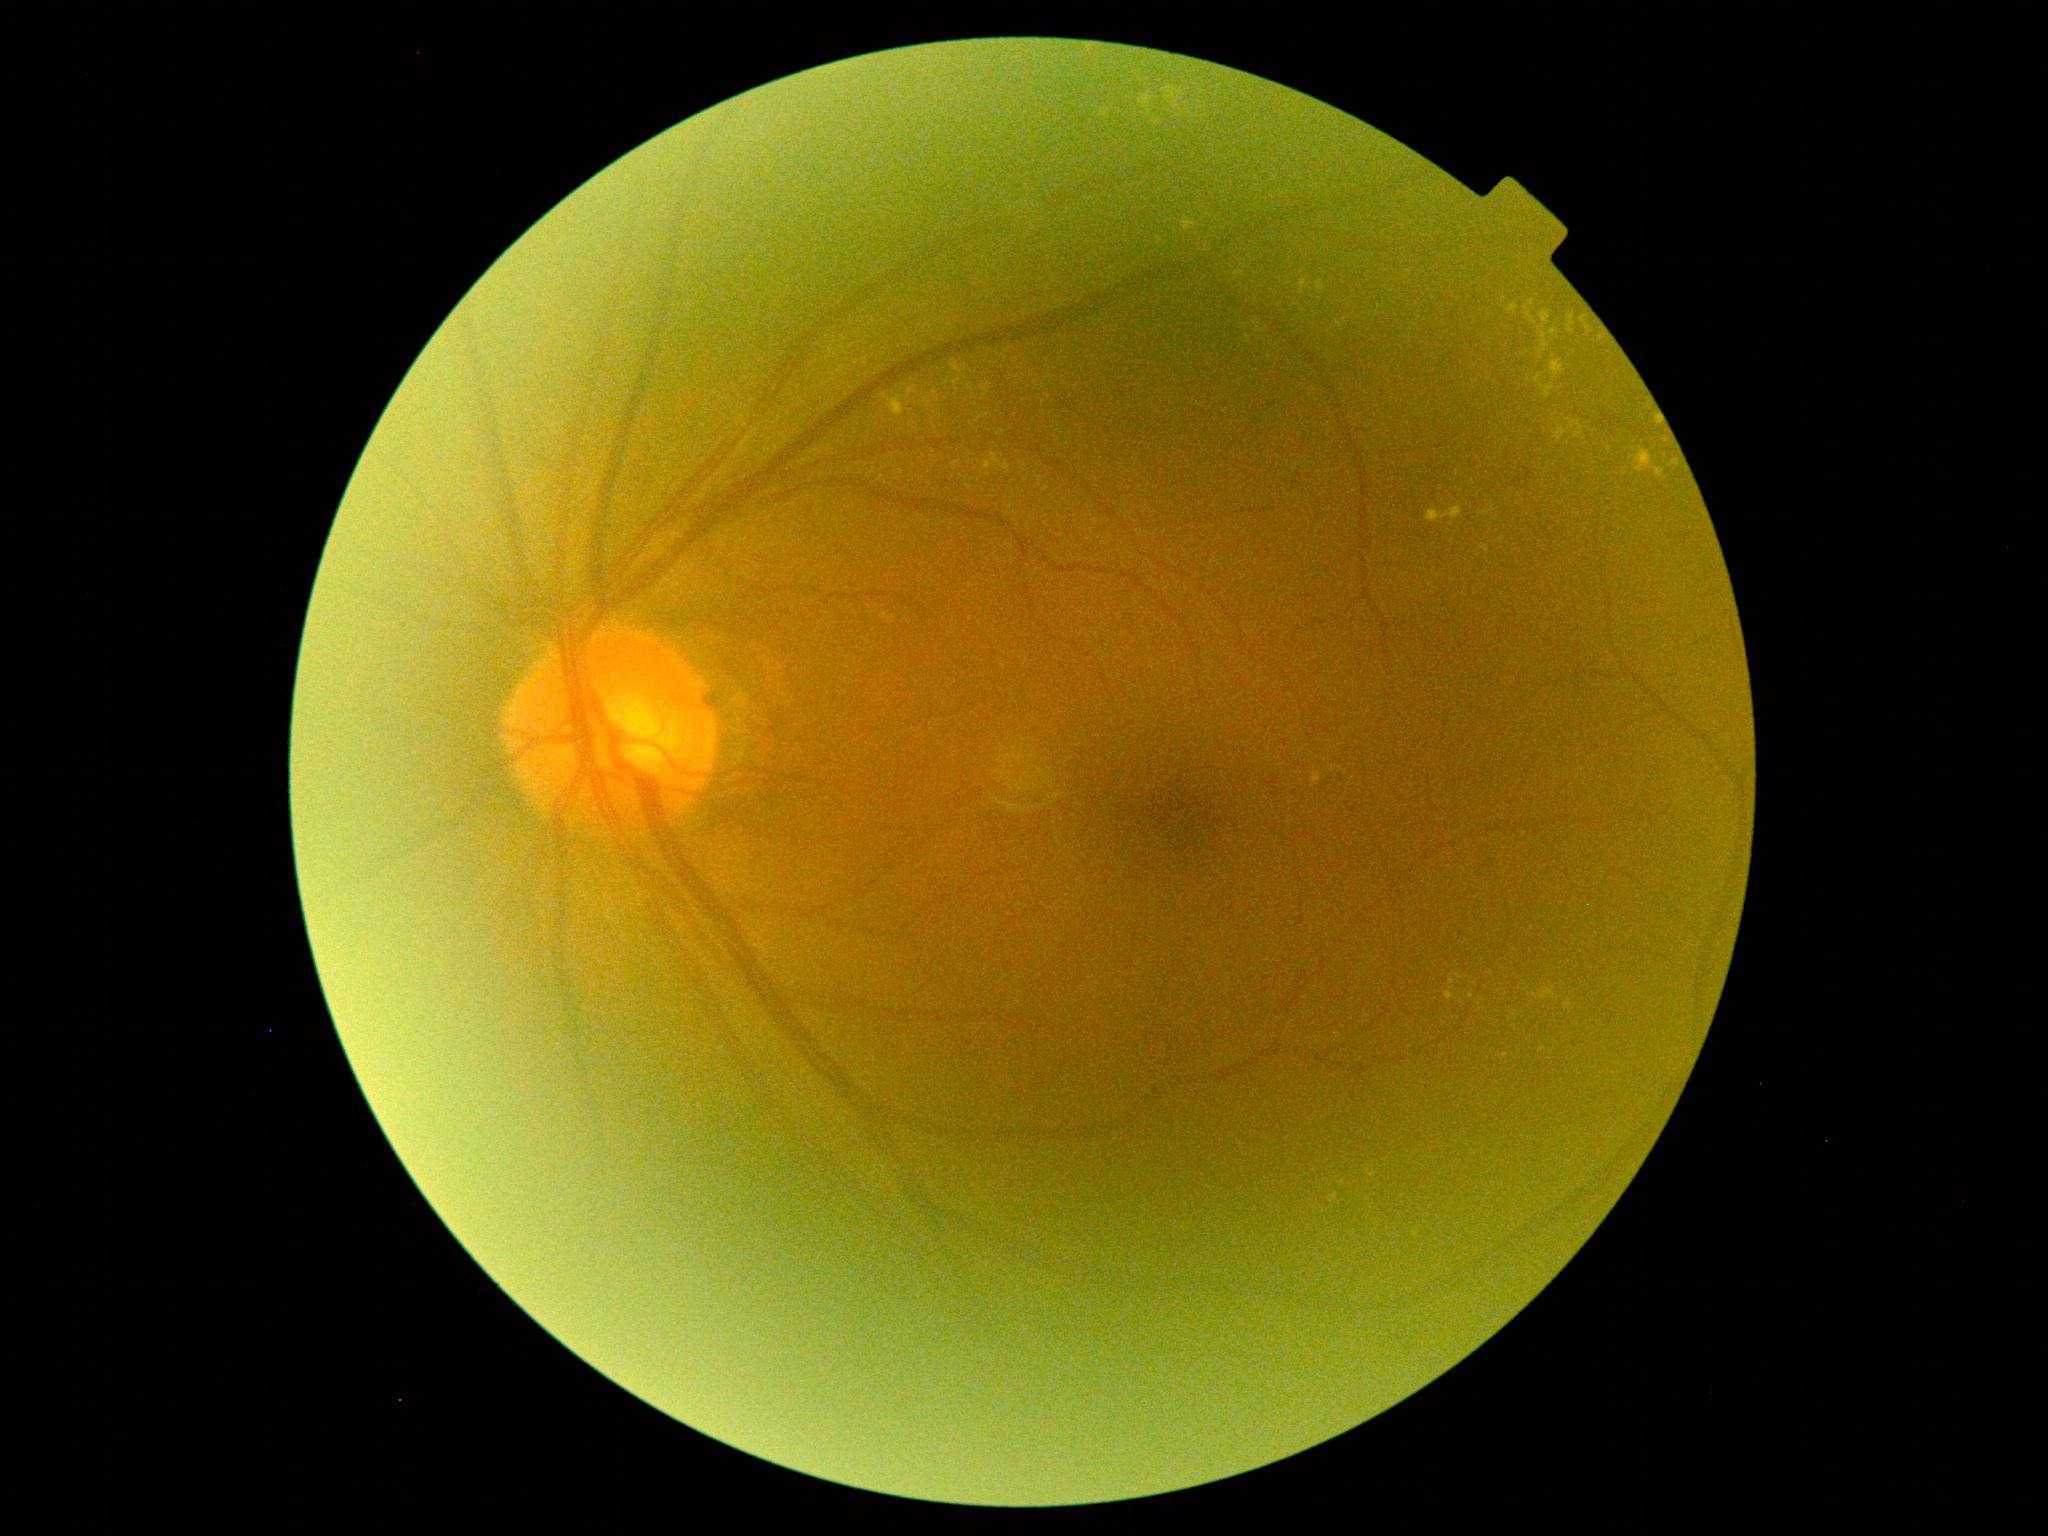
Diabetic retinopathy grade is 2.